Wide-field fundus photograph of an infant. Clarity RetCam 3, 130° FOV: 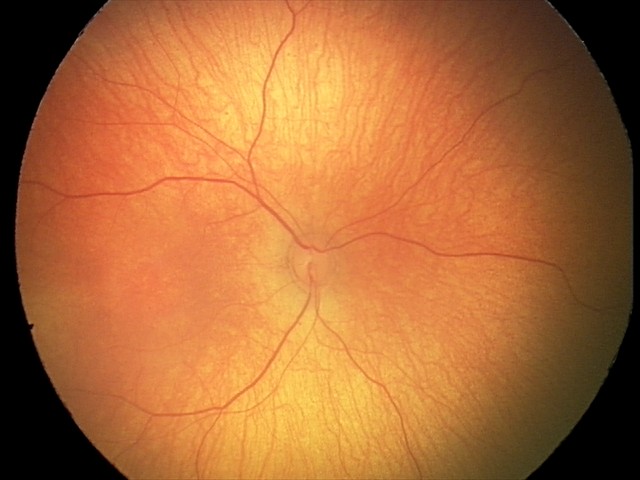 Impression: normal fundus examination.